100° field of view (Phoenix ICON). Infant wide-field fundus photograph. 1240x1240px
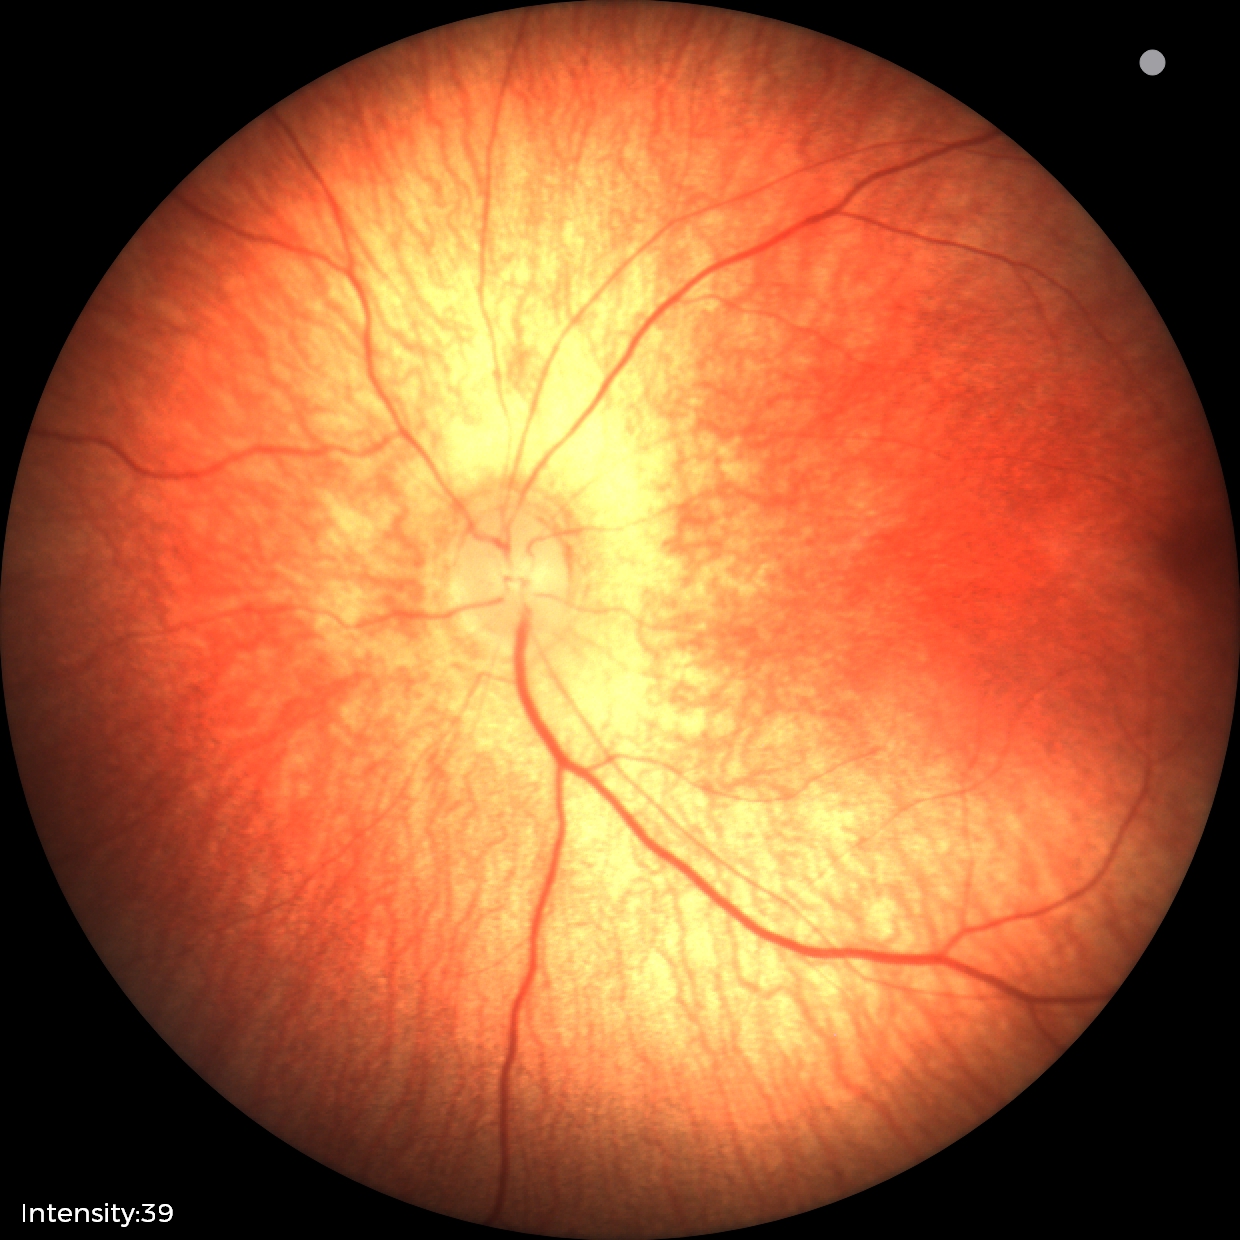
Screening examination with no abnormal retinal findings.